Image size 1240x1240 · pediatric retinal photograph (wide-field): 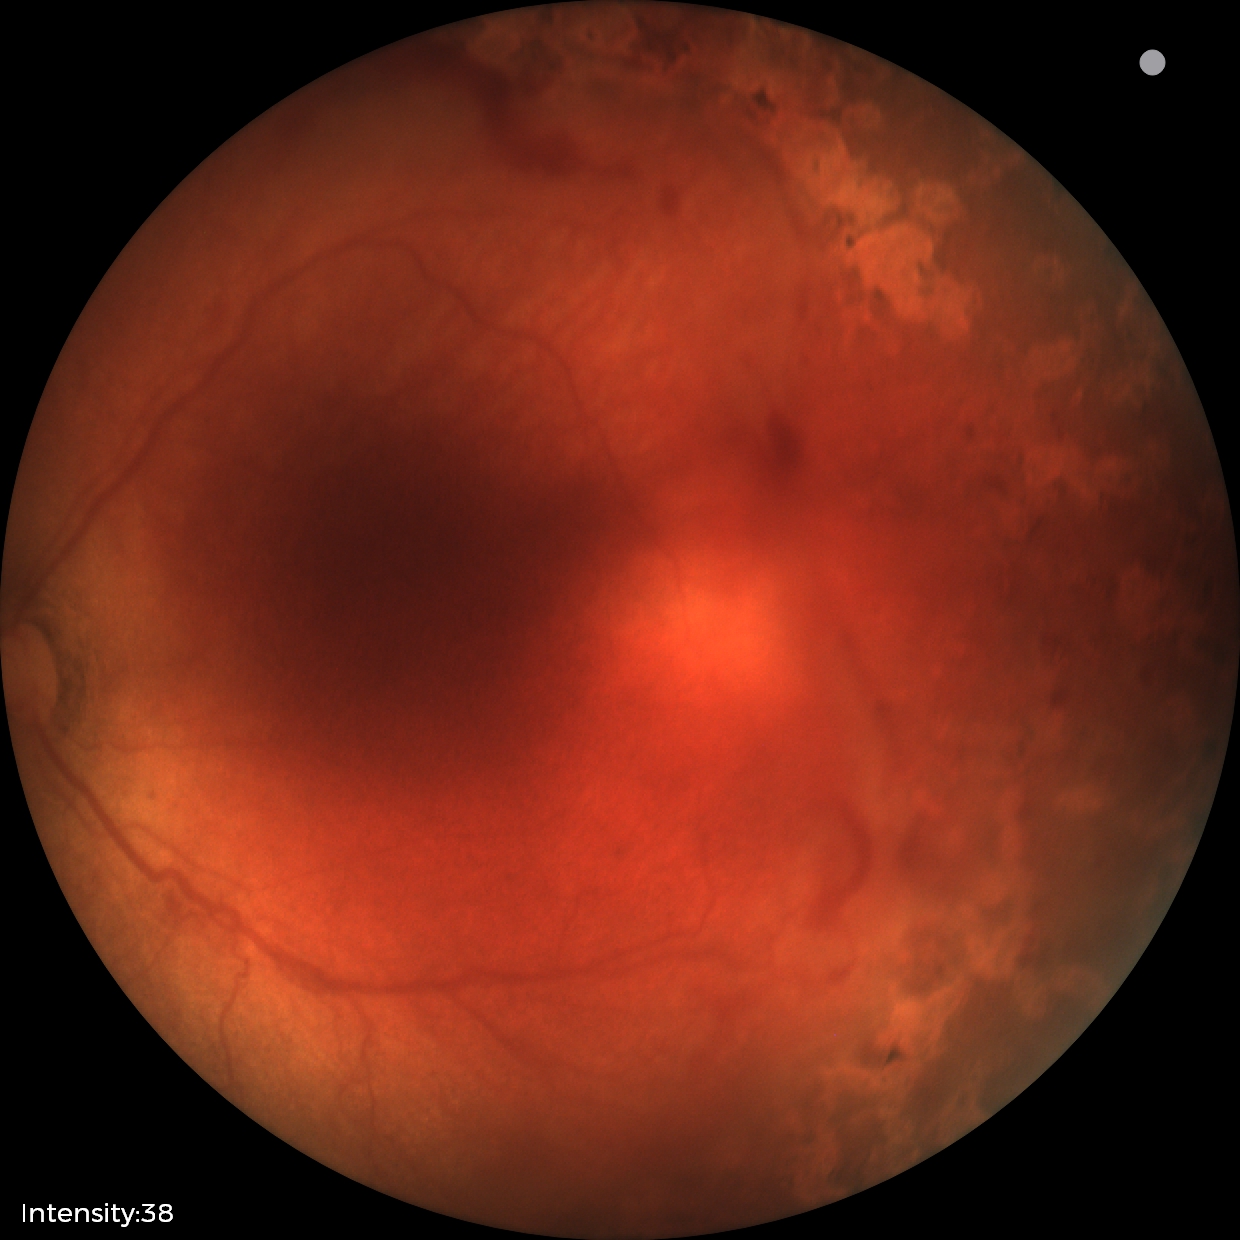

Plus form: absent
diagnosis: status post ROP — retinal appearance after treated retinopathy of prematurity